45-degree field of view; image size 1932x1916; fundus photo.
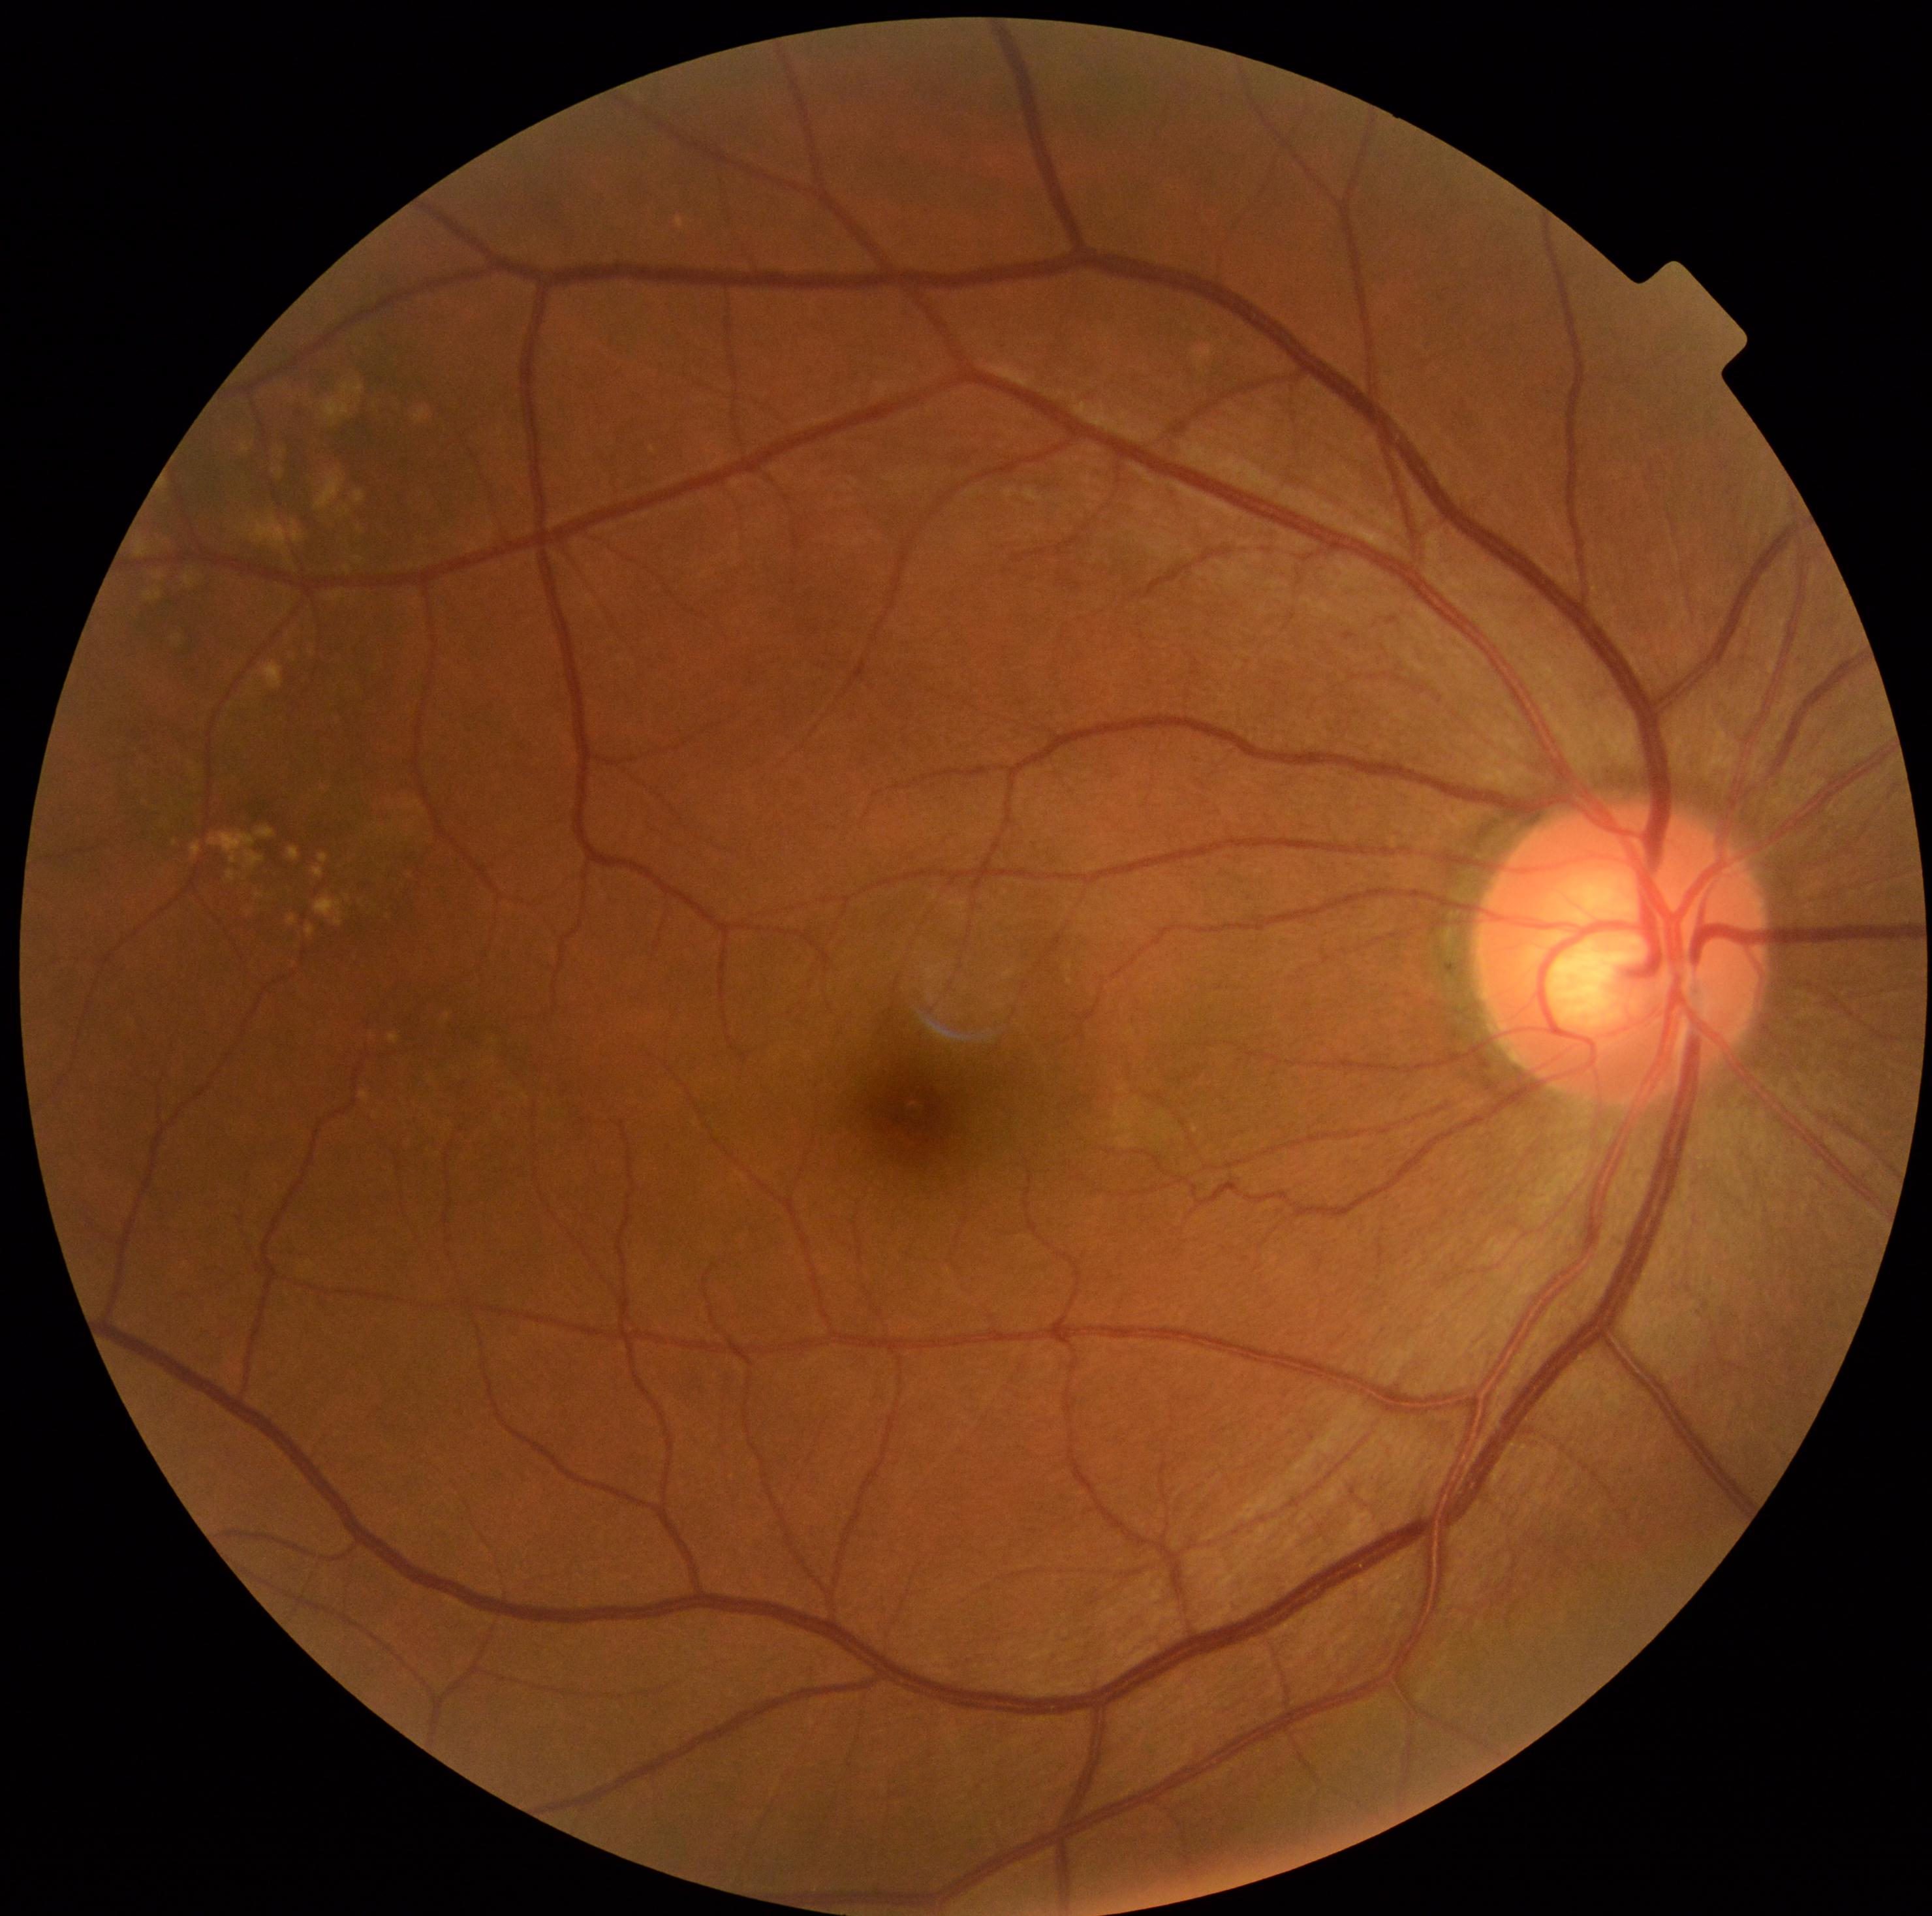

Diabetic retinopathy: 0/4.